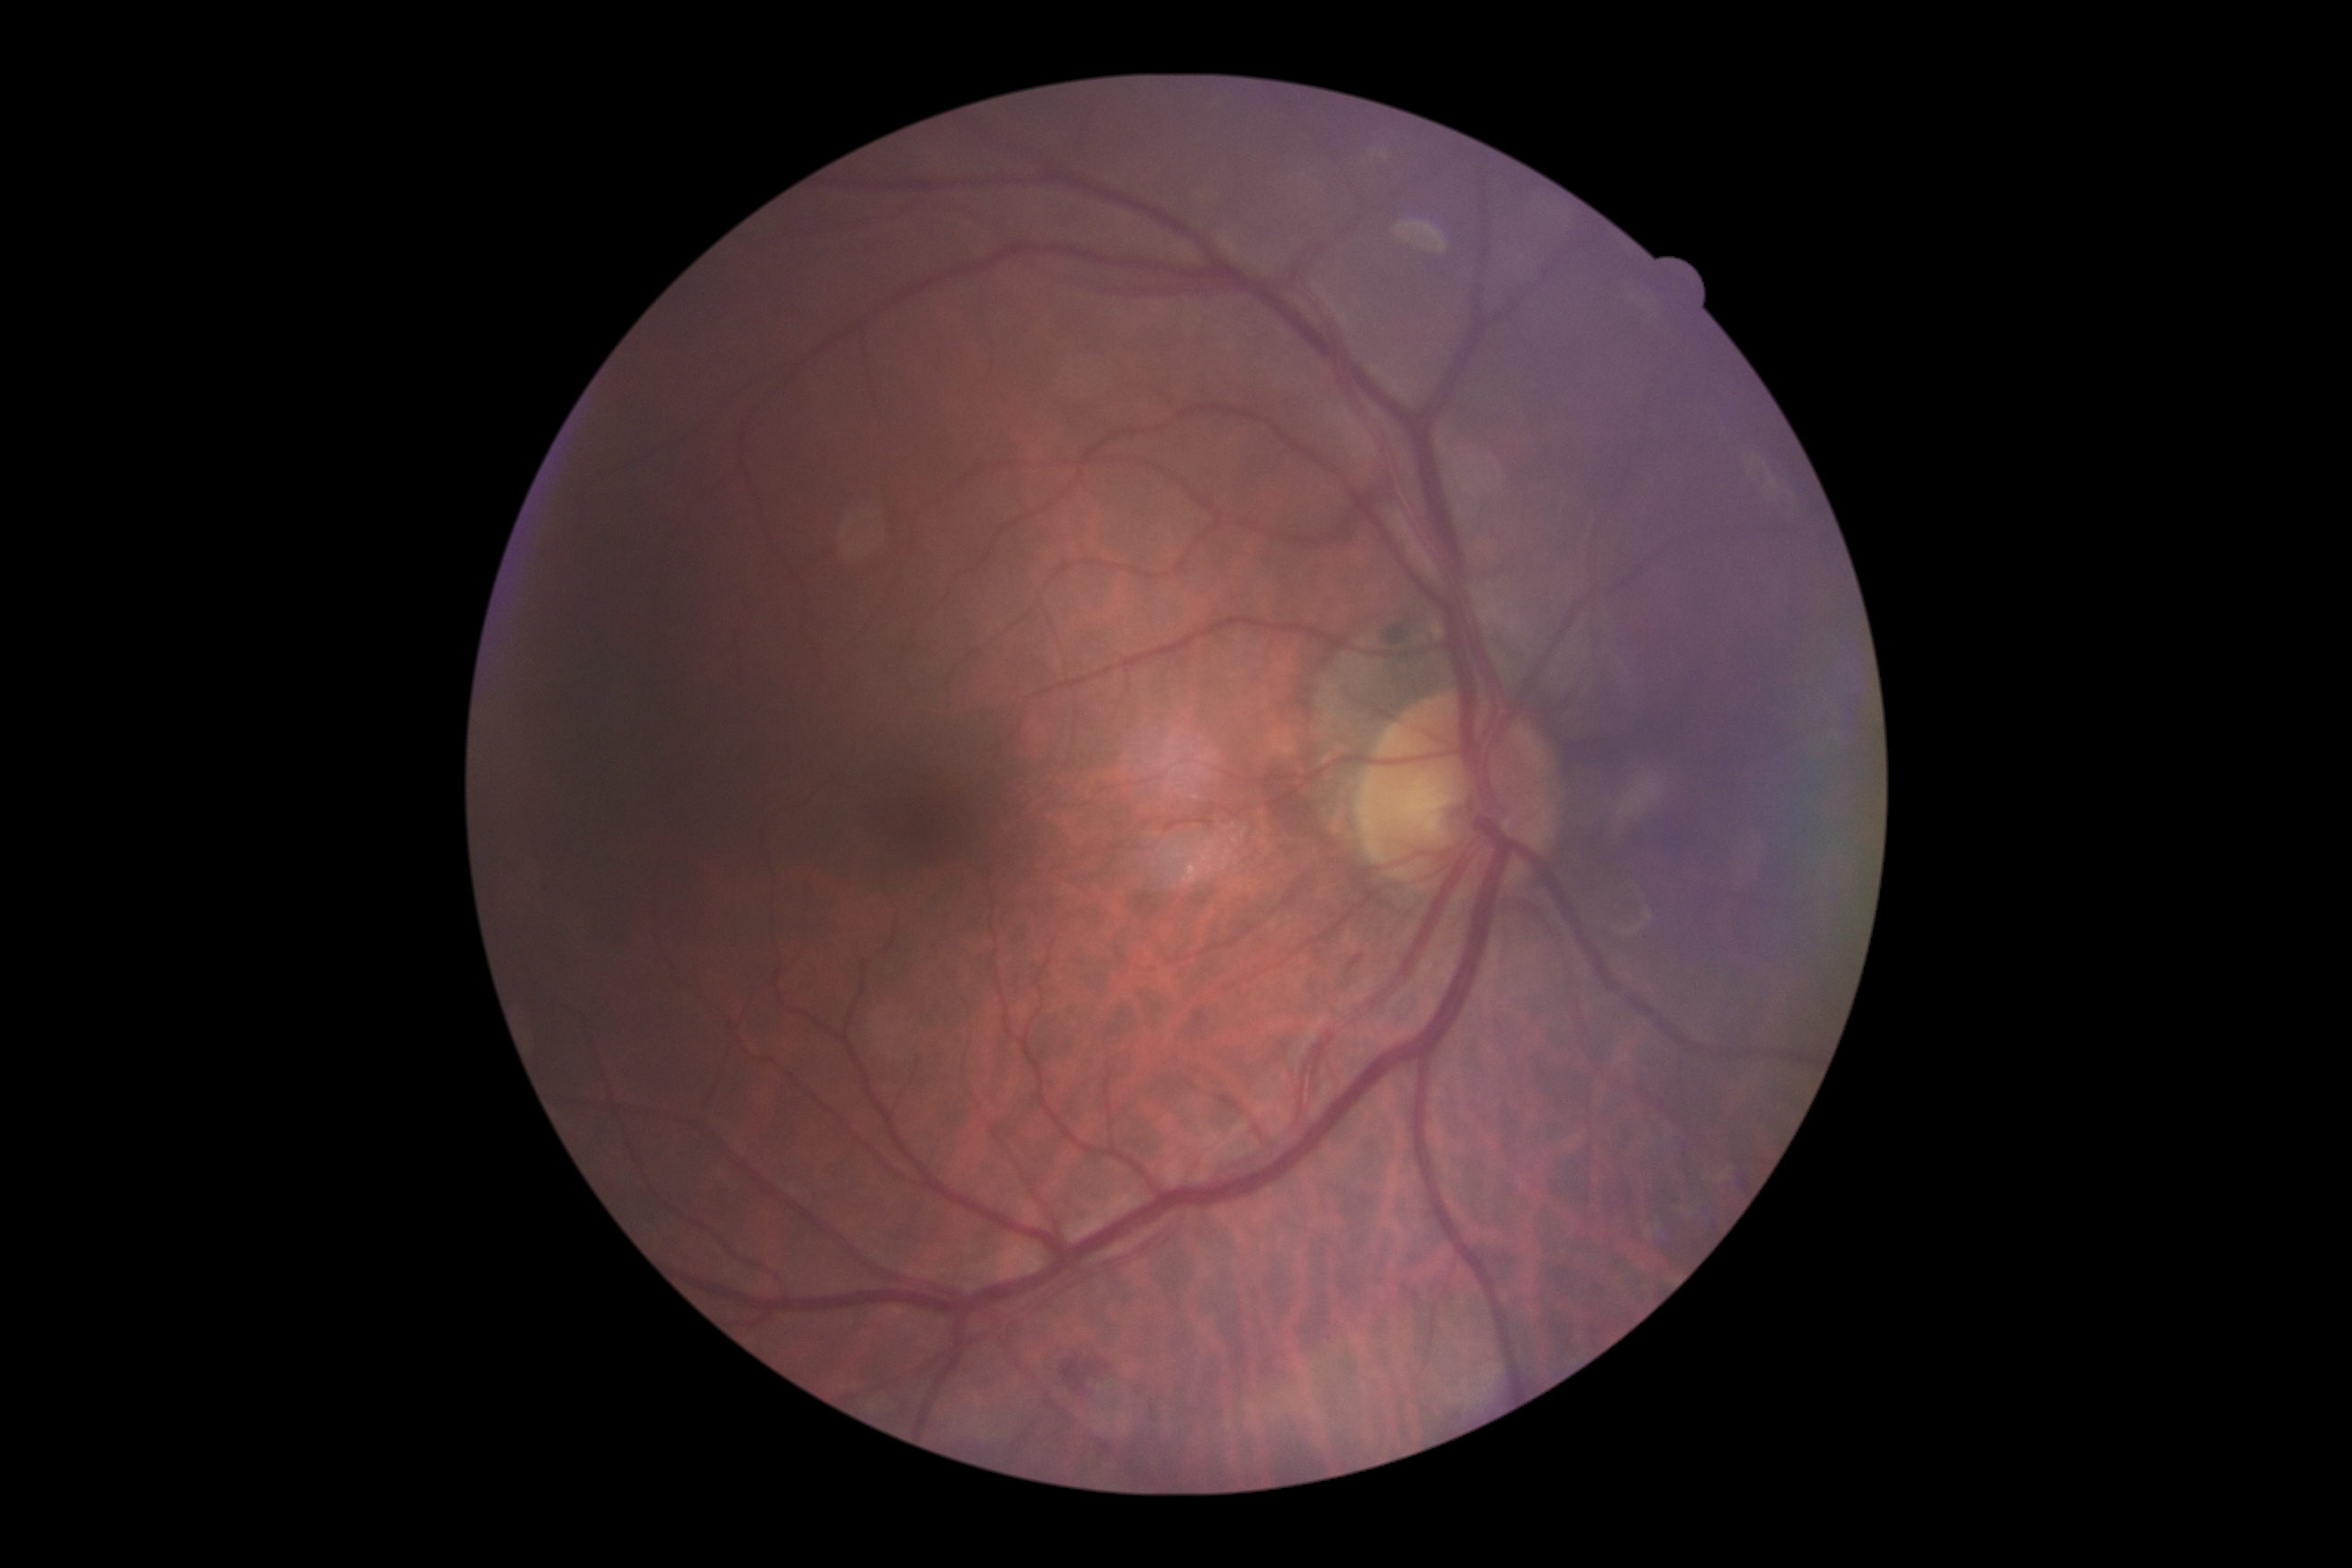
diabetic retinopathy (DR) = grade 2